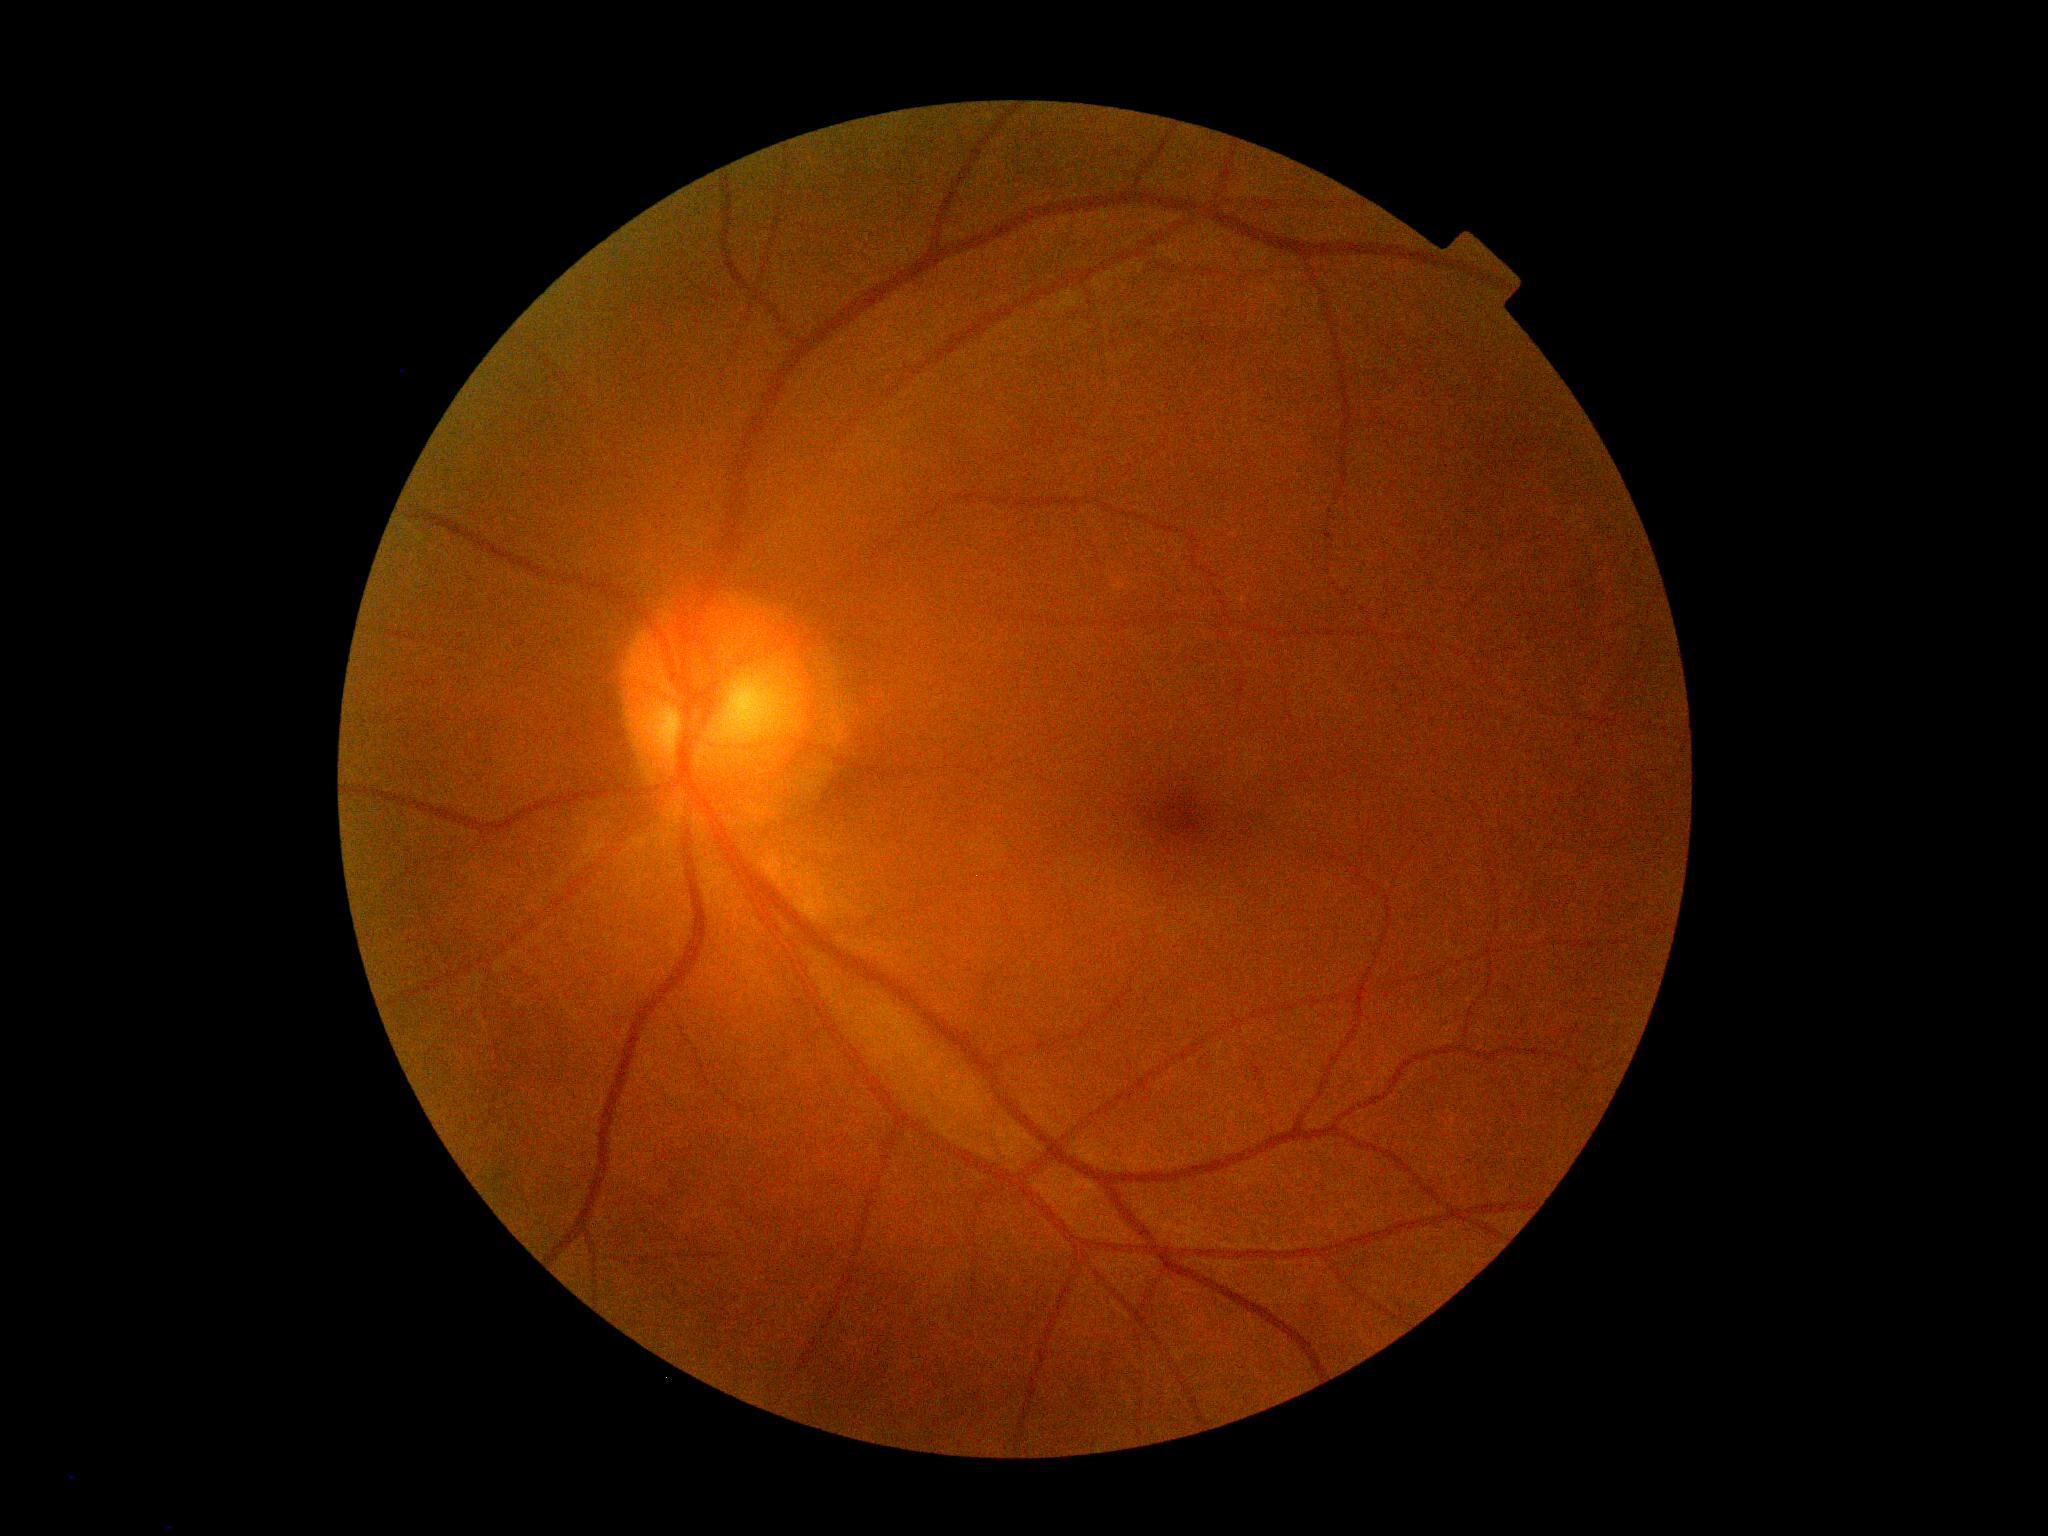
Diabetic retinopathy (DR): grade 0 (no apparent retinopathy).
No apparent diabetic retinopathy.